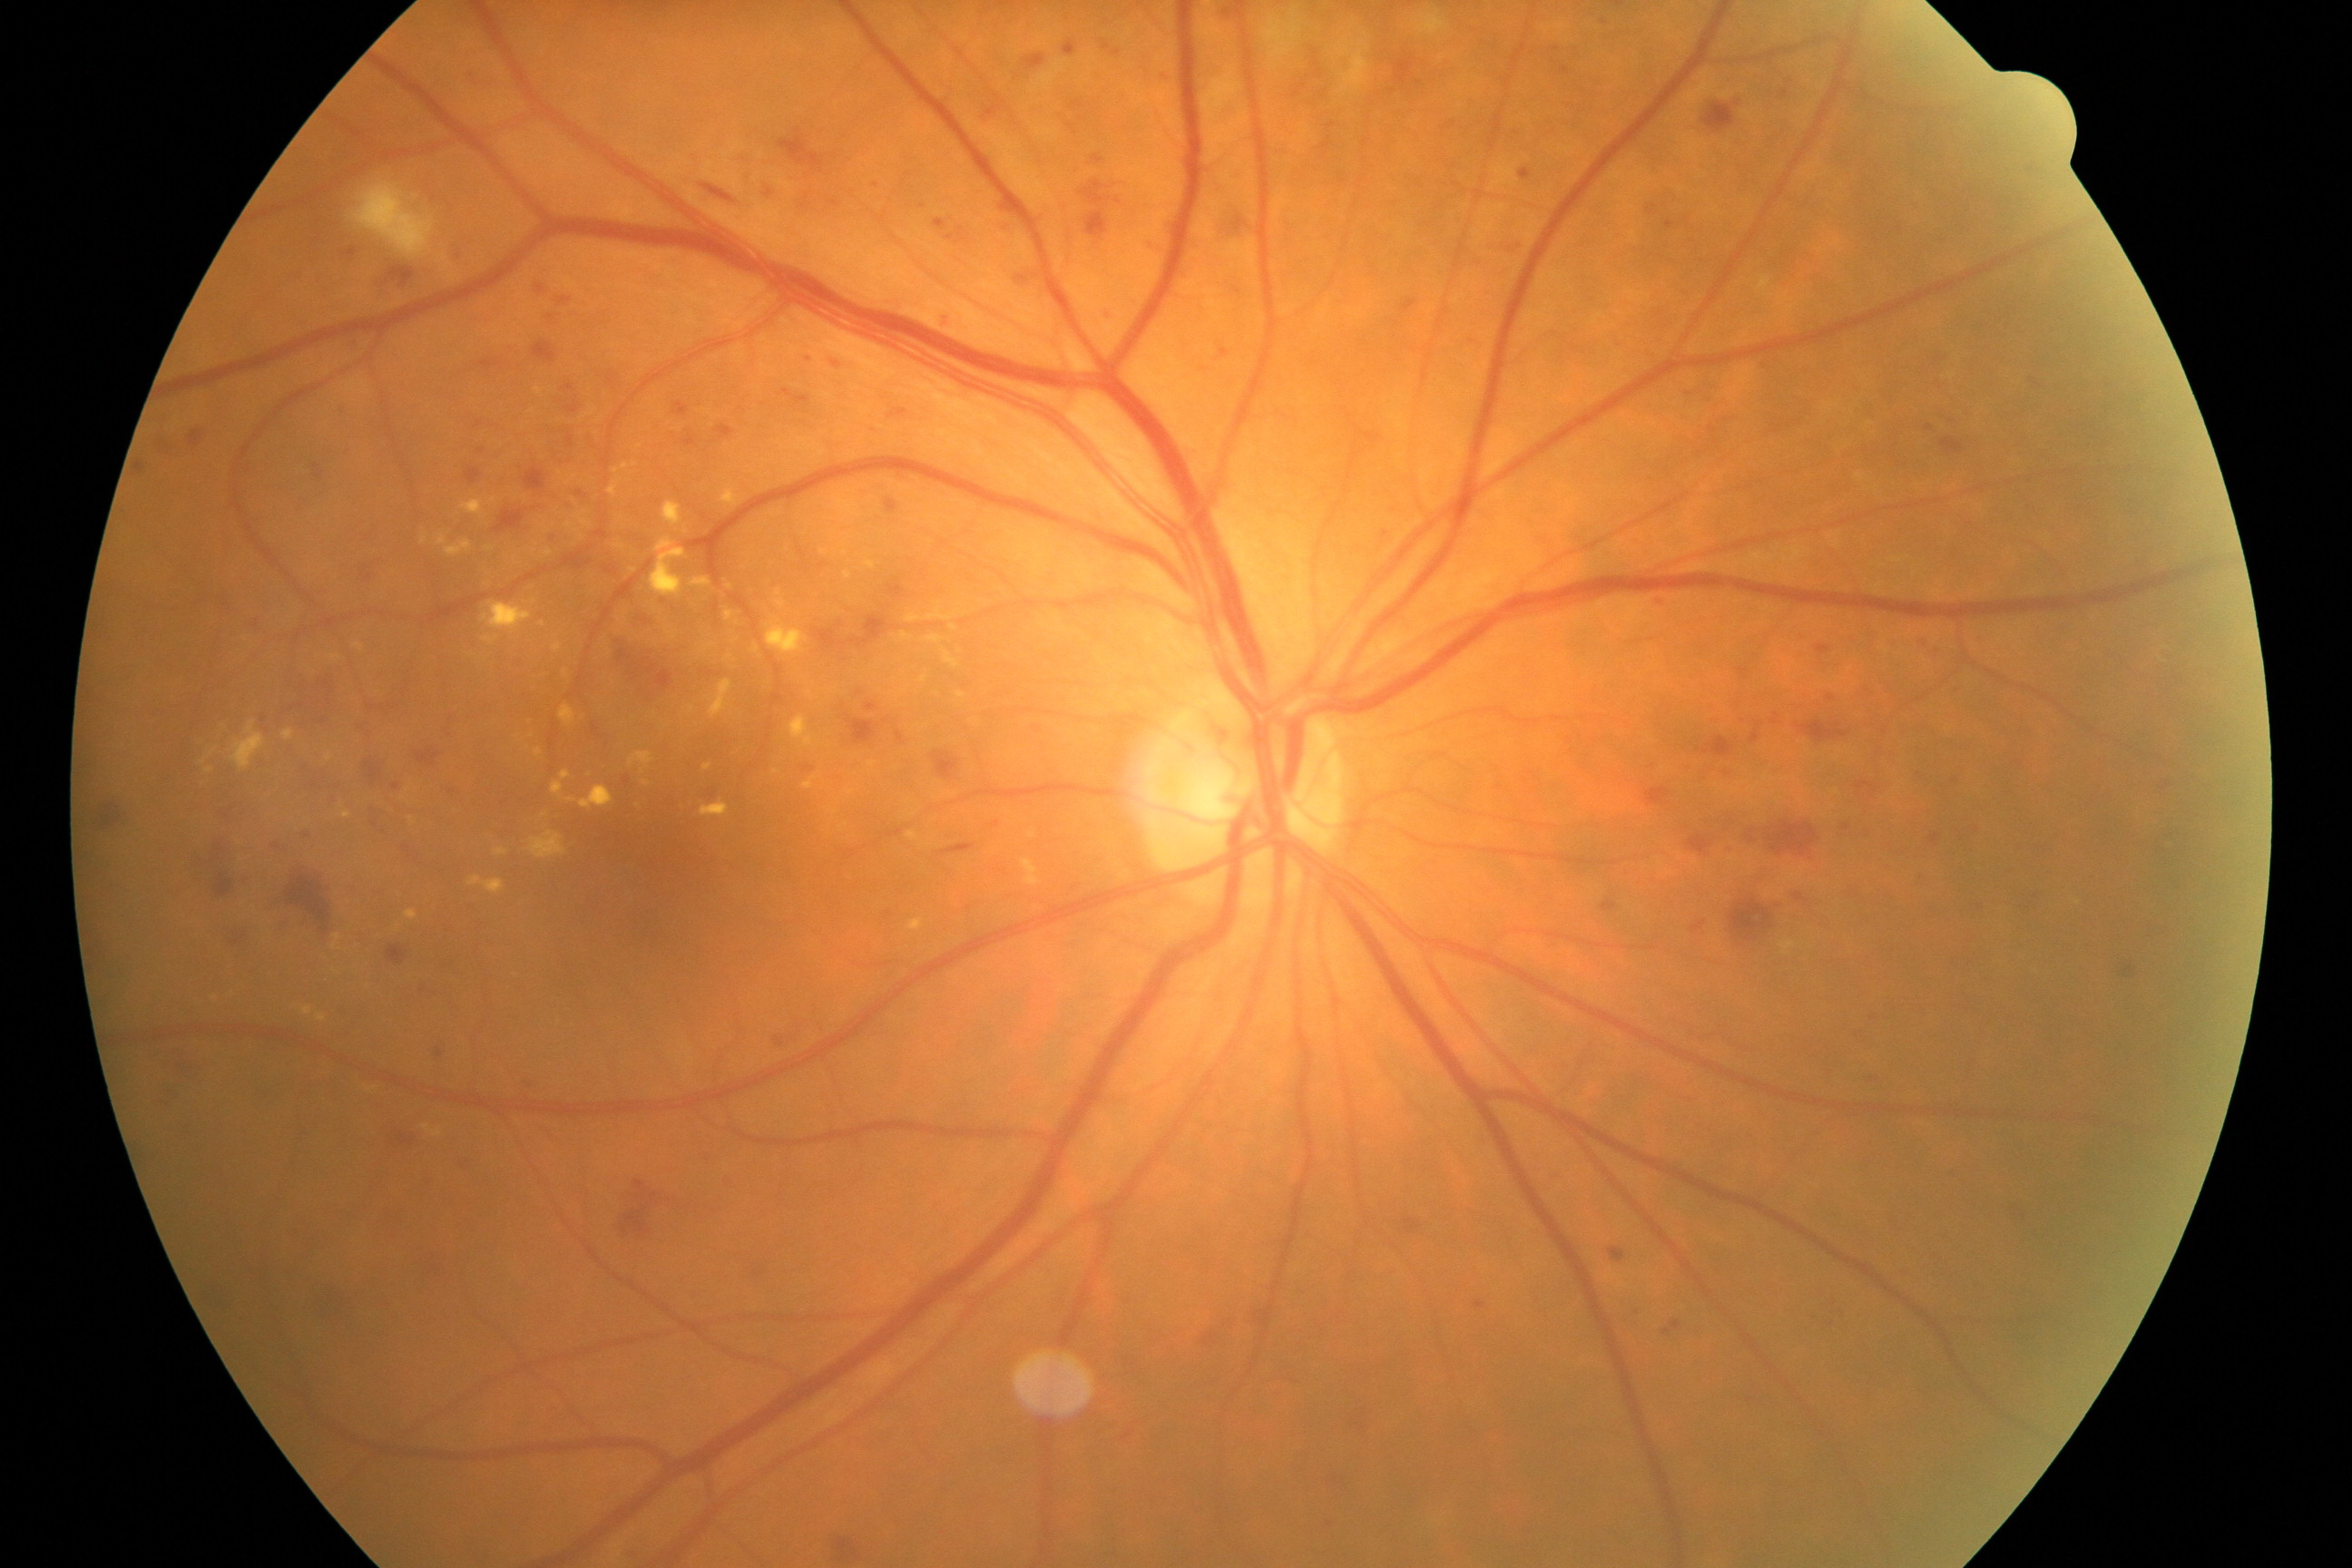
There is evidence of moderate non-proliferative diabetic retinopathy. Features include microaneurysms with dot and blot hemorrhages or hard exudates, less than severe non-proliferative diabetic retinopathy, and/or with diabetic macular edema.